848x848px; no pharmacologic dilation.
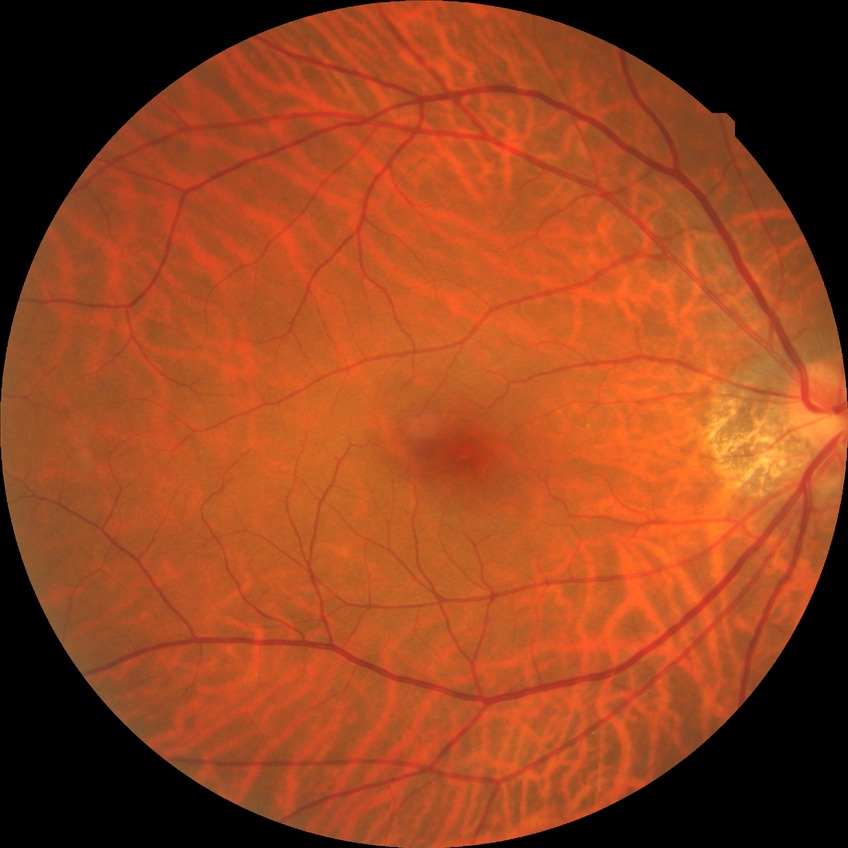
Diabetic retinopathy (DR): NDR (no diabetic retinopathy).